CFP:
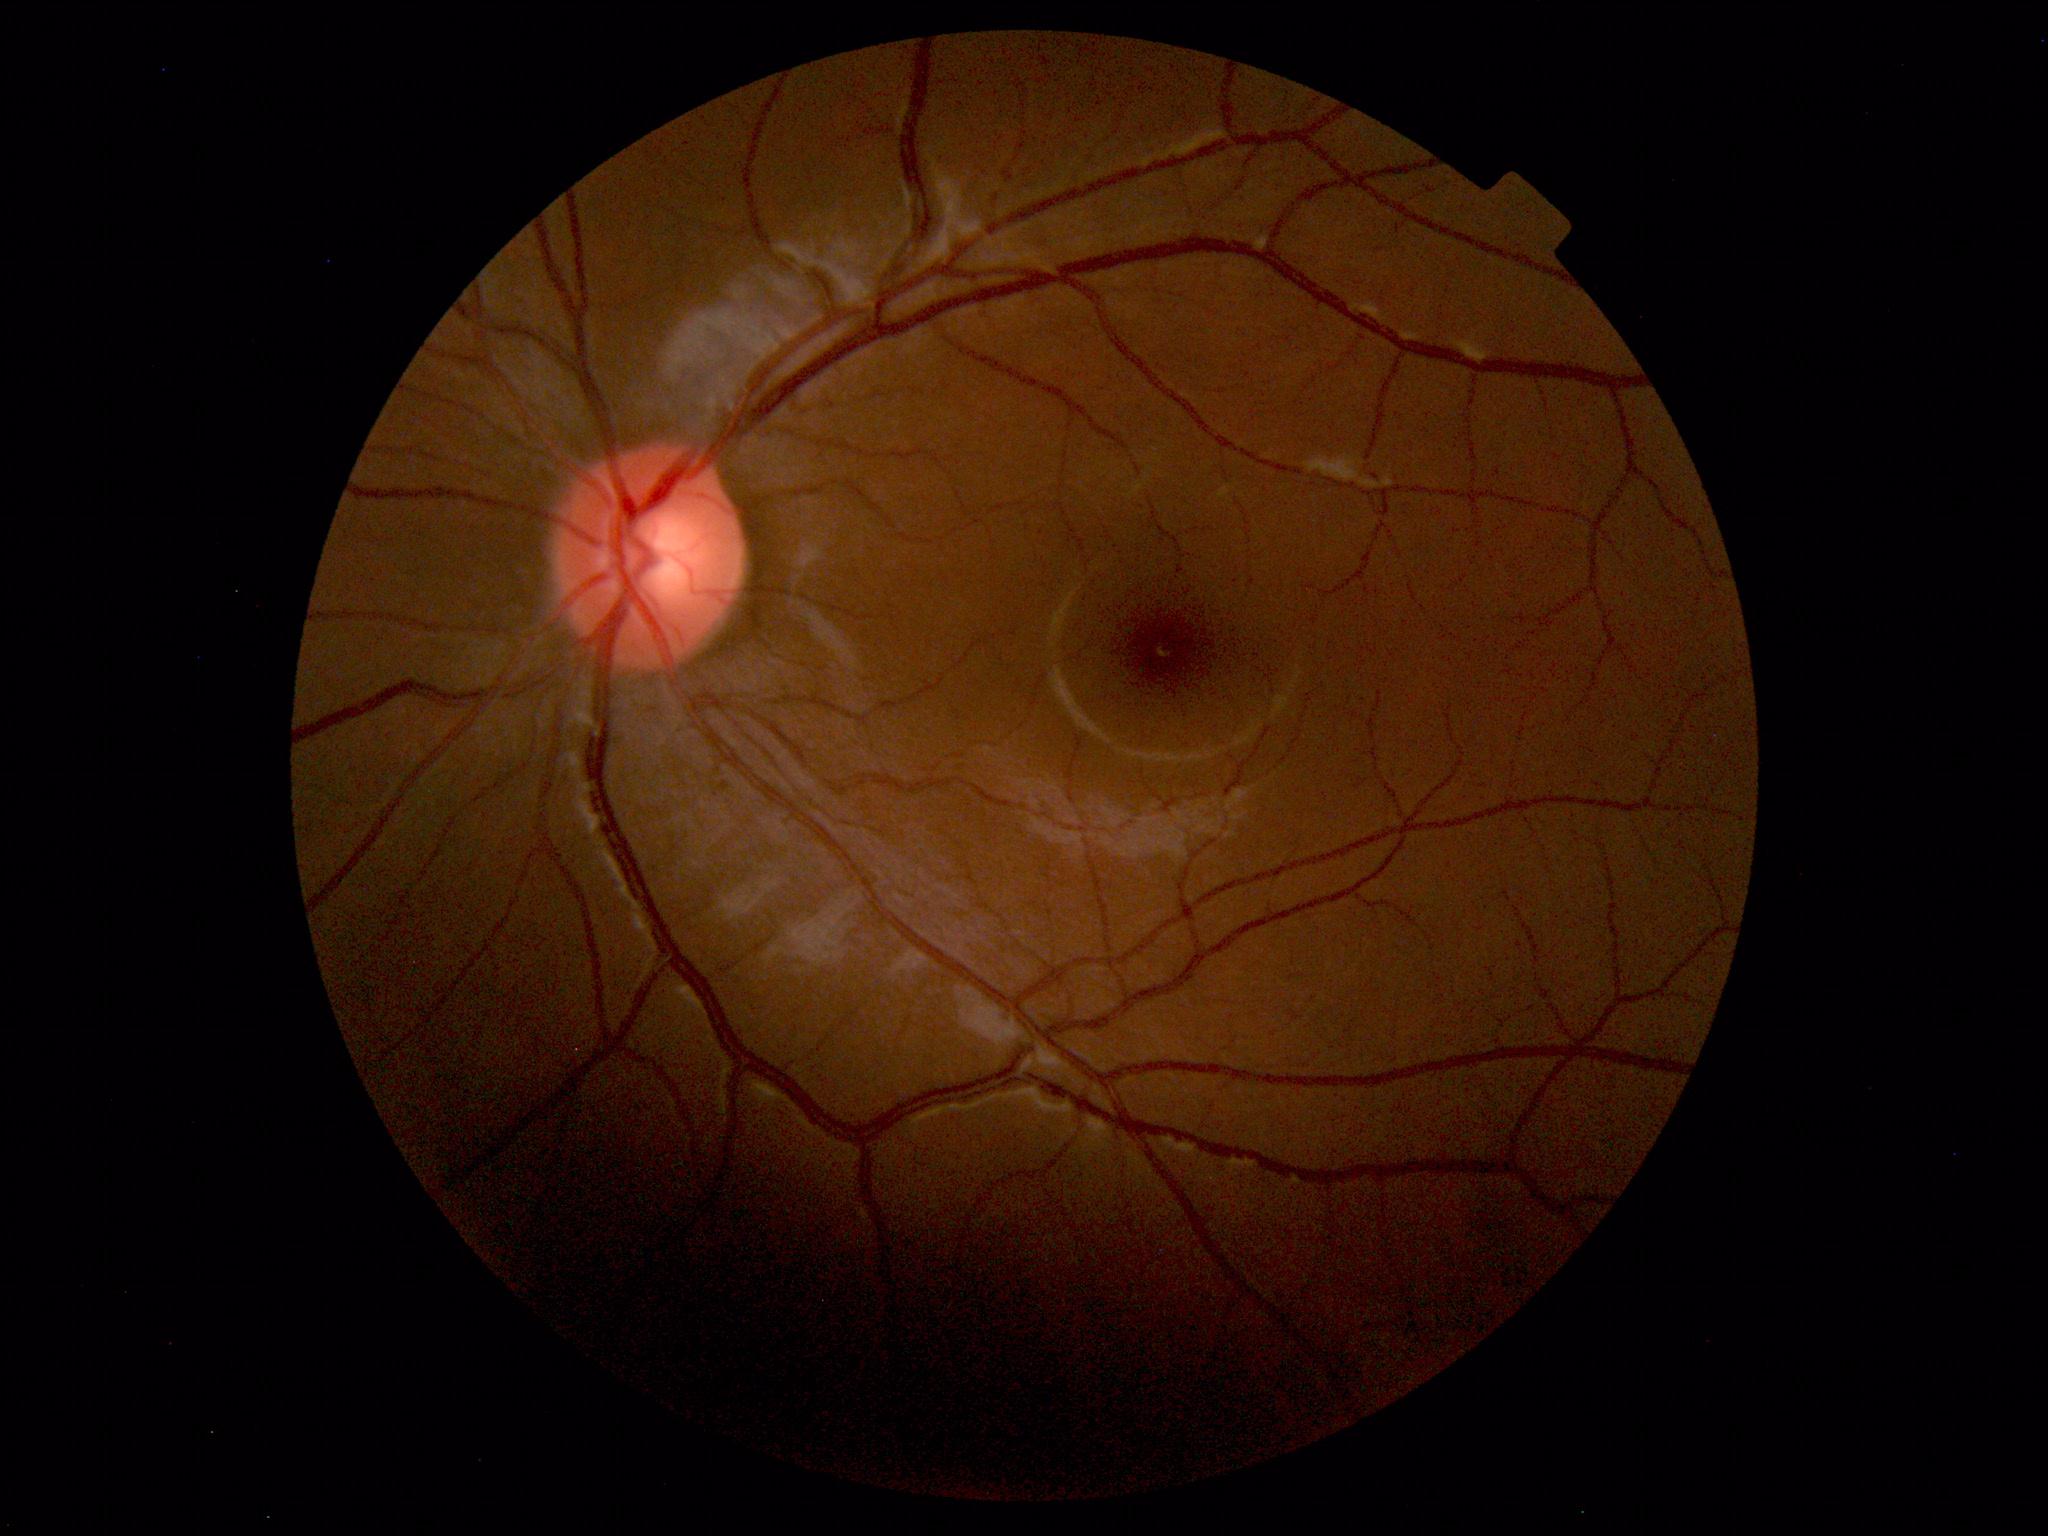

Findings: none. Normal fundus.